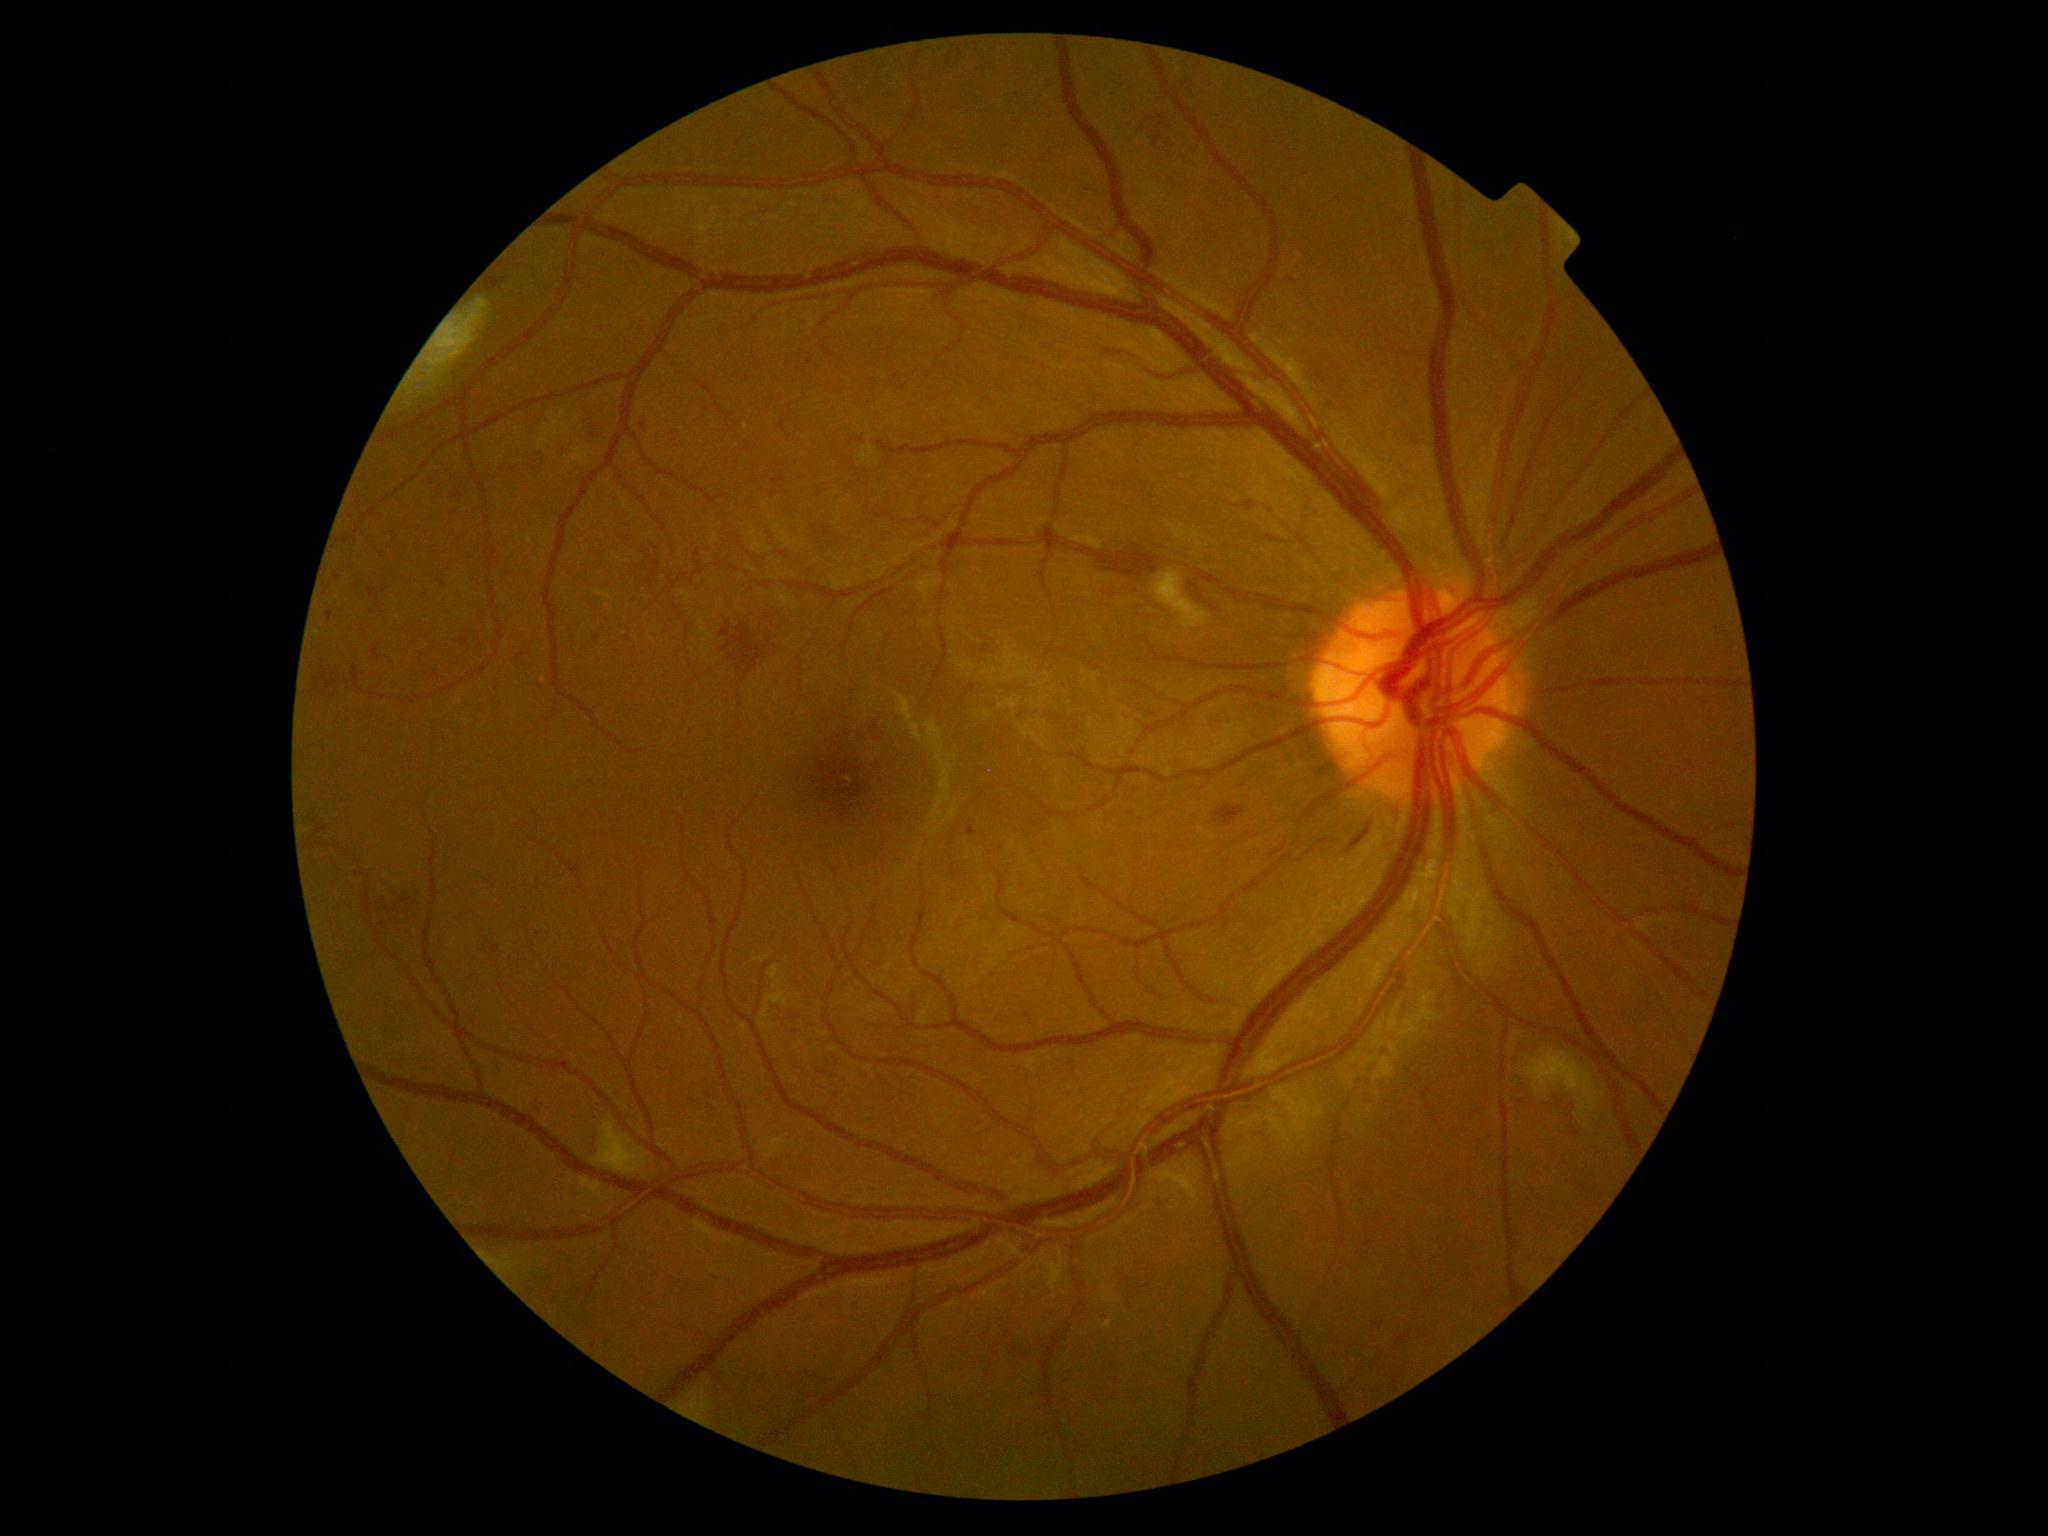
diabetic retinopathy (DR): moderate NPDR (grade 2).